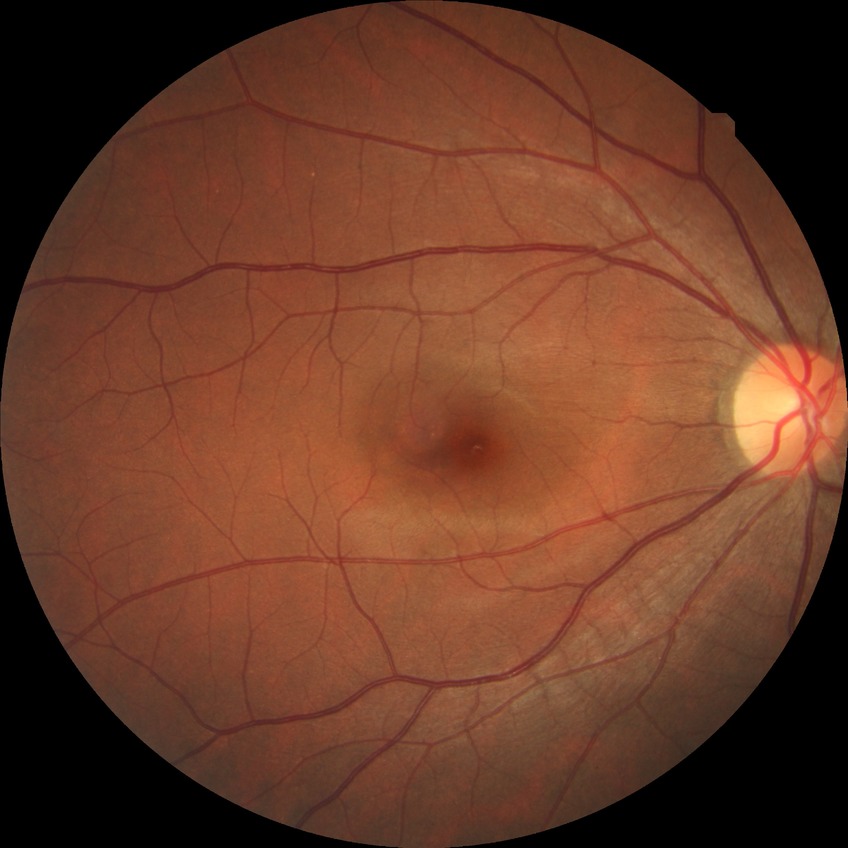
diabetic retinopathy (DR): NDR (no diabetic retinopathy).